CFP, 45° field of view:
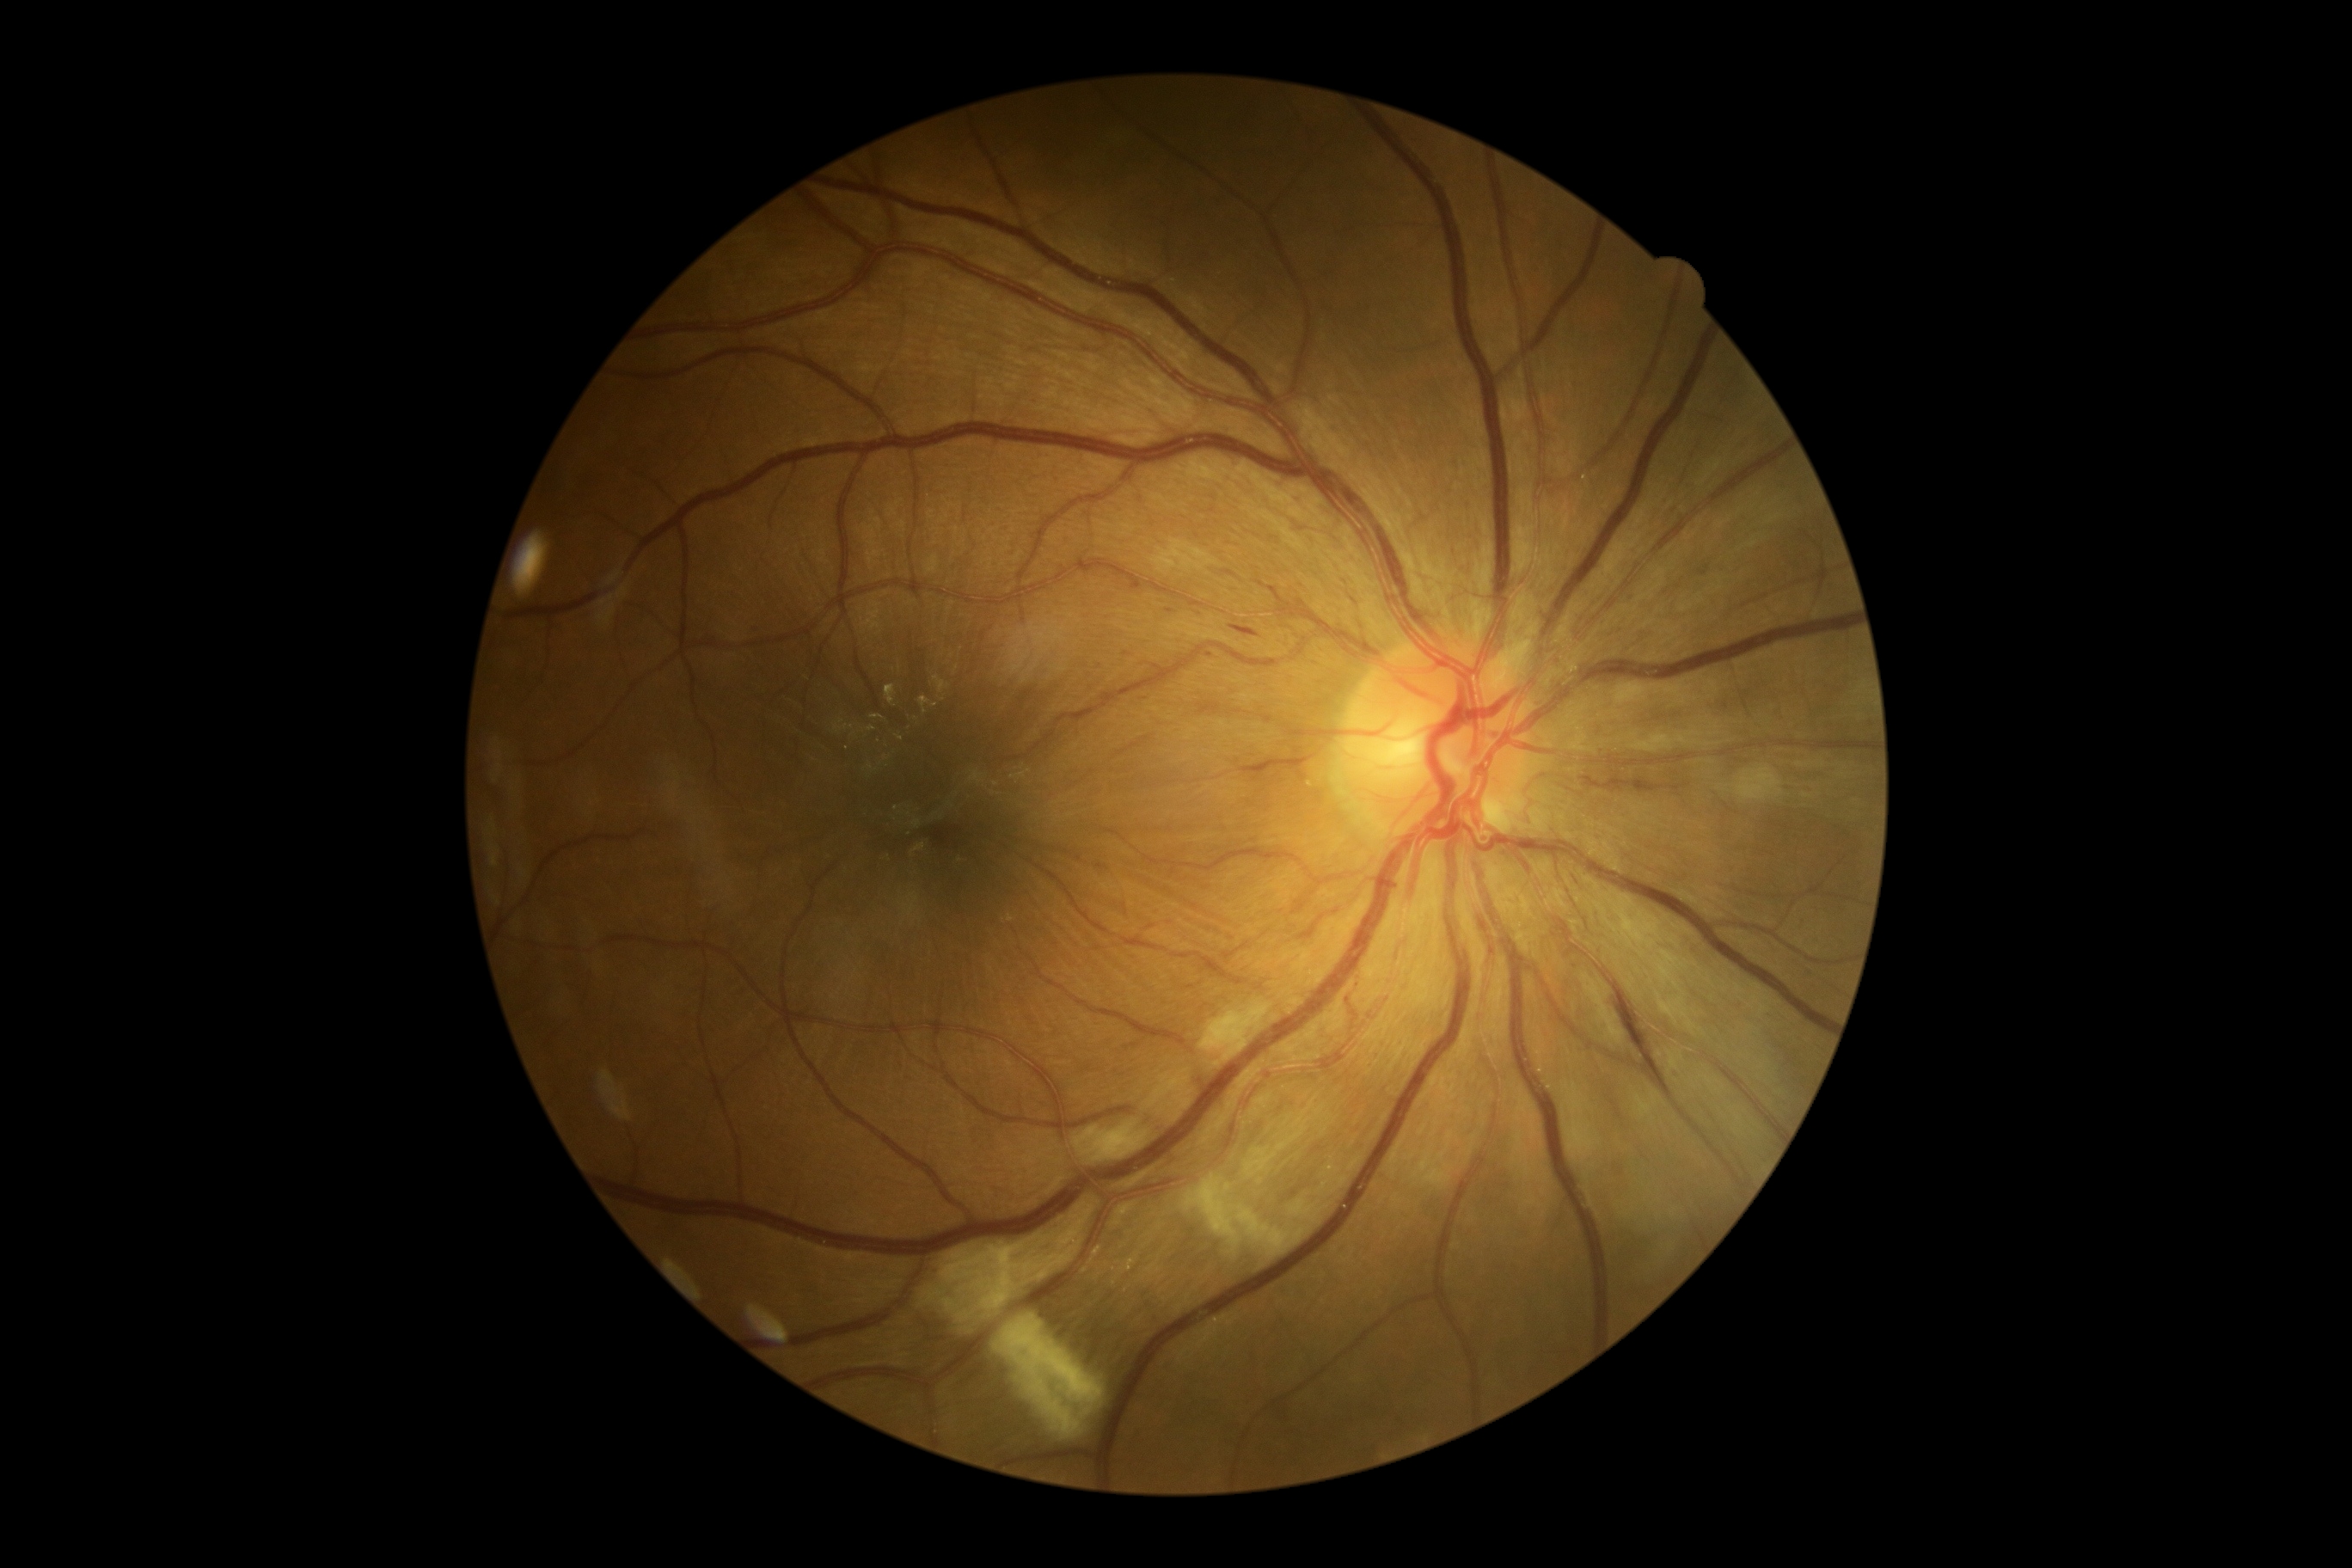
Diabetic retinopathy (DR) is moderate non-proliferative diabetic retinopathy (grade 2). Hemorrhages (HEs) identified at {"x1": 1610, "y1": 998, "x2": 1648, "y2": 1072}; {"x1": 1235, "y1": 627, "x2": 1259, "y2": 639}. Hard exudates (EXs) (partial list) at {"x1": 867, "y1": 726, "x2": 878, "y2": 732}; {"x1": 871, "y1": 714, "x2": 885, "y2": 720}; {"x1": 867, "y1": 764, "x2": 874, "y2": 773}; {"x1": 933, "y1": 677, "x2": 950, "y2": 694}; {"x1": 886, "y1": 685, "x2": 897, "y2": 707}; {"x1": 835, "y1": 720, "x2": 854, "y2": 735}; {"x1": 919, "y1": 697, "x2": 938, "y2": 714}. Small EXs approximately at (900; 737); (887; 758); (854; 735); (943; 700). Microaneurysms (MAs) identified at {"x1": 1206, "y1": 654, "x2": 1213, "y2": 663}. Small MAs approximately at (1169; 611). Soft exudates (SEs) identified at {"x1": 1246, "y1": 1096, "x2": 1318, "y2": 1179}; {"x1": 1184, "y1": 1175, "x2": 1306, "y2": 1256}; {"x1": 953, "y1": 1254, "x2": 962, "y2": 1261}; {"x1": 1201, "y1": 1003, "x2": 1270, "y2": 1060}; {"x1": 1737, "y1": 766, "x2": 1785, "y2": 802}; {"x1": 919, "y1": 1290, "x2": 938, "y2": 1308}; {"x1": 995, "y1": 1313, "x2": 1105, "y2": 1438}; {"x1": 943, "y1": 1208, "x2": 1093, "y2": 1318}; {"x1": 1022, "y1": 1282, "x2": 1031, "y2": 1285}; {"x1": 1074, "y1": 1120, "x2": 1148, "y2": 1163}; {"x1": 955, "y1": 1313, "x2": 972, "y2": 1323}; {"x1": 943, "y1": 1299, "x2": 957, "y2": 1313}. Small SEs approximately at (962; 1290).